848x848px
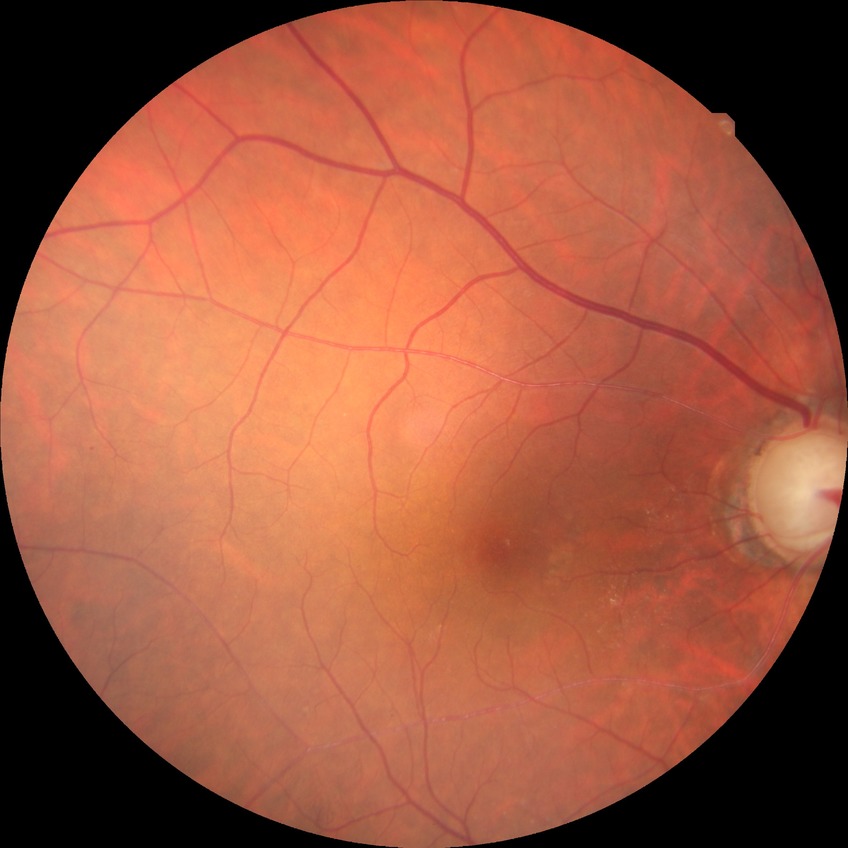

Davis stage=PPDR.